CFP; 45 degree fundus photograph; graded on the modified Davis scale.
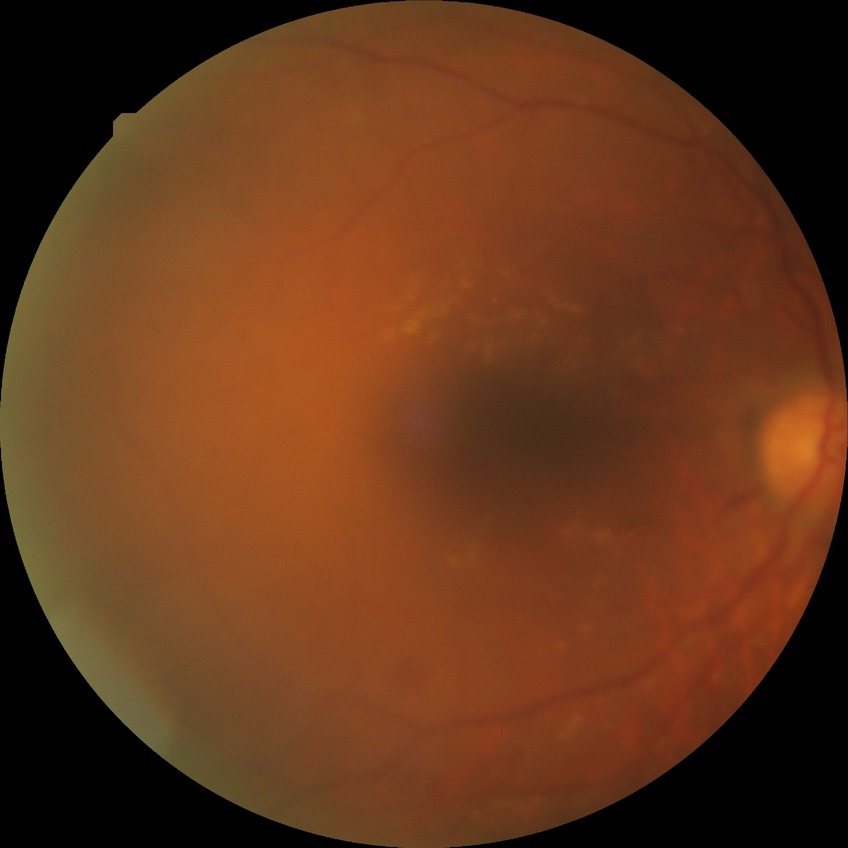
DR grade: PPDR.